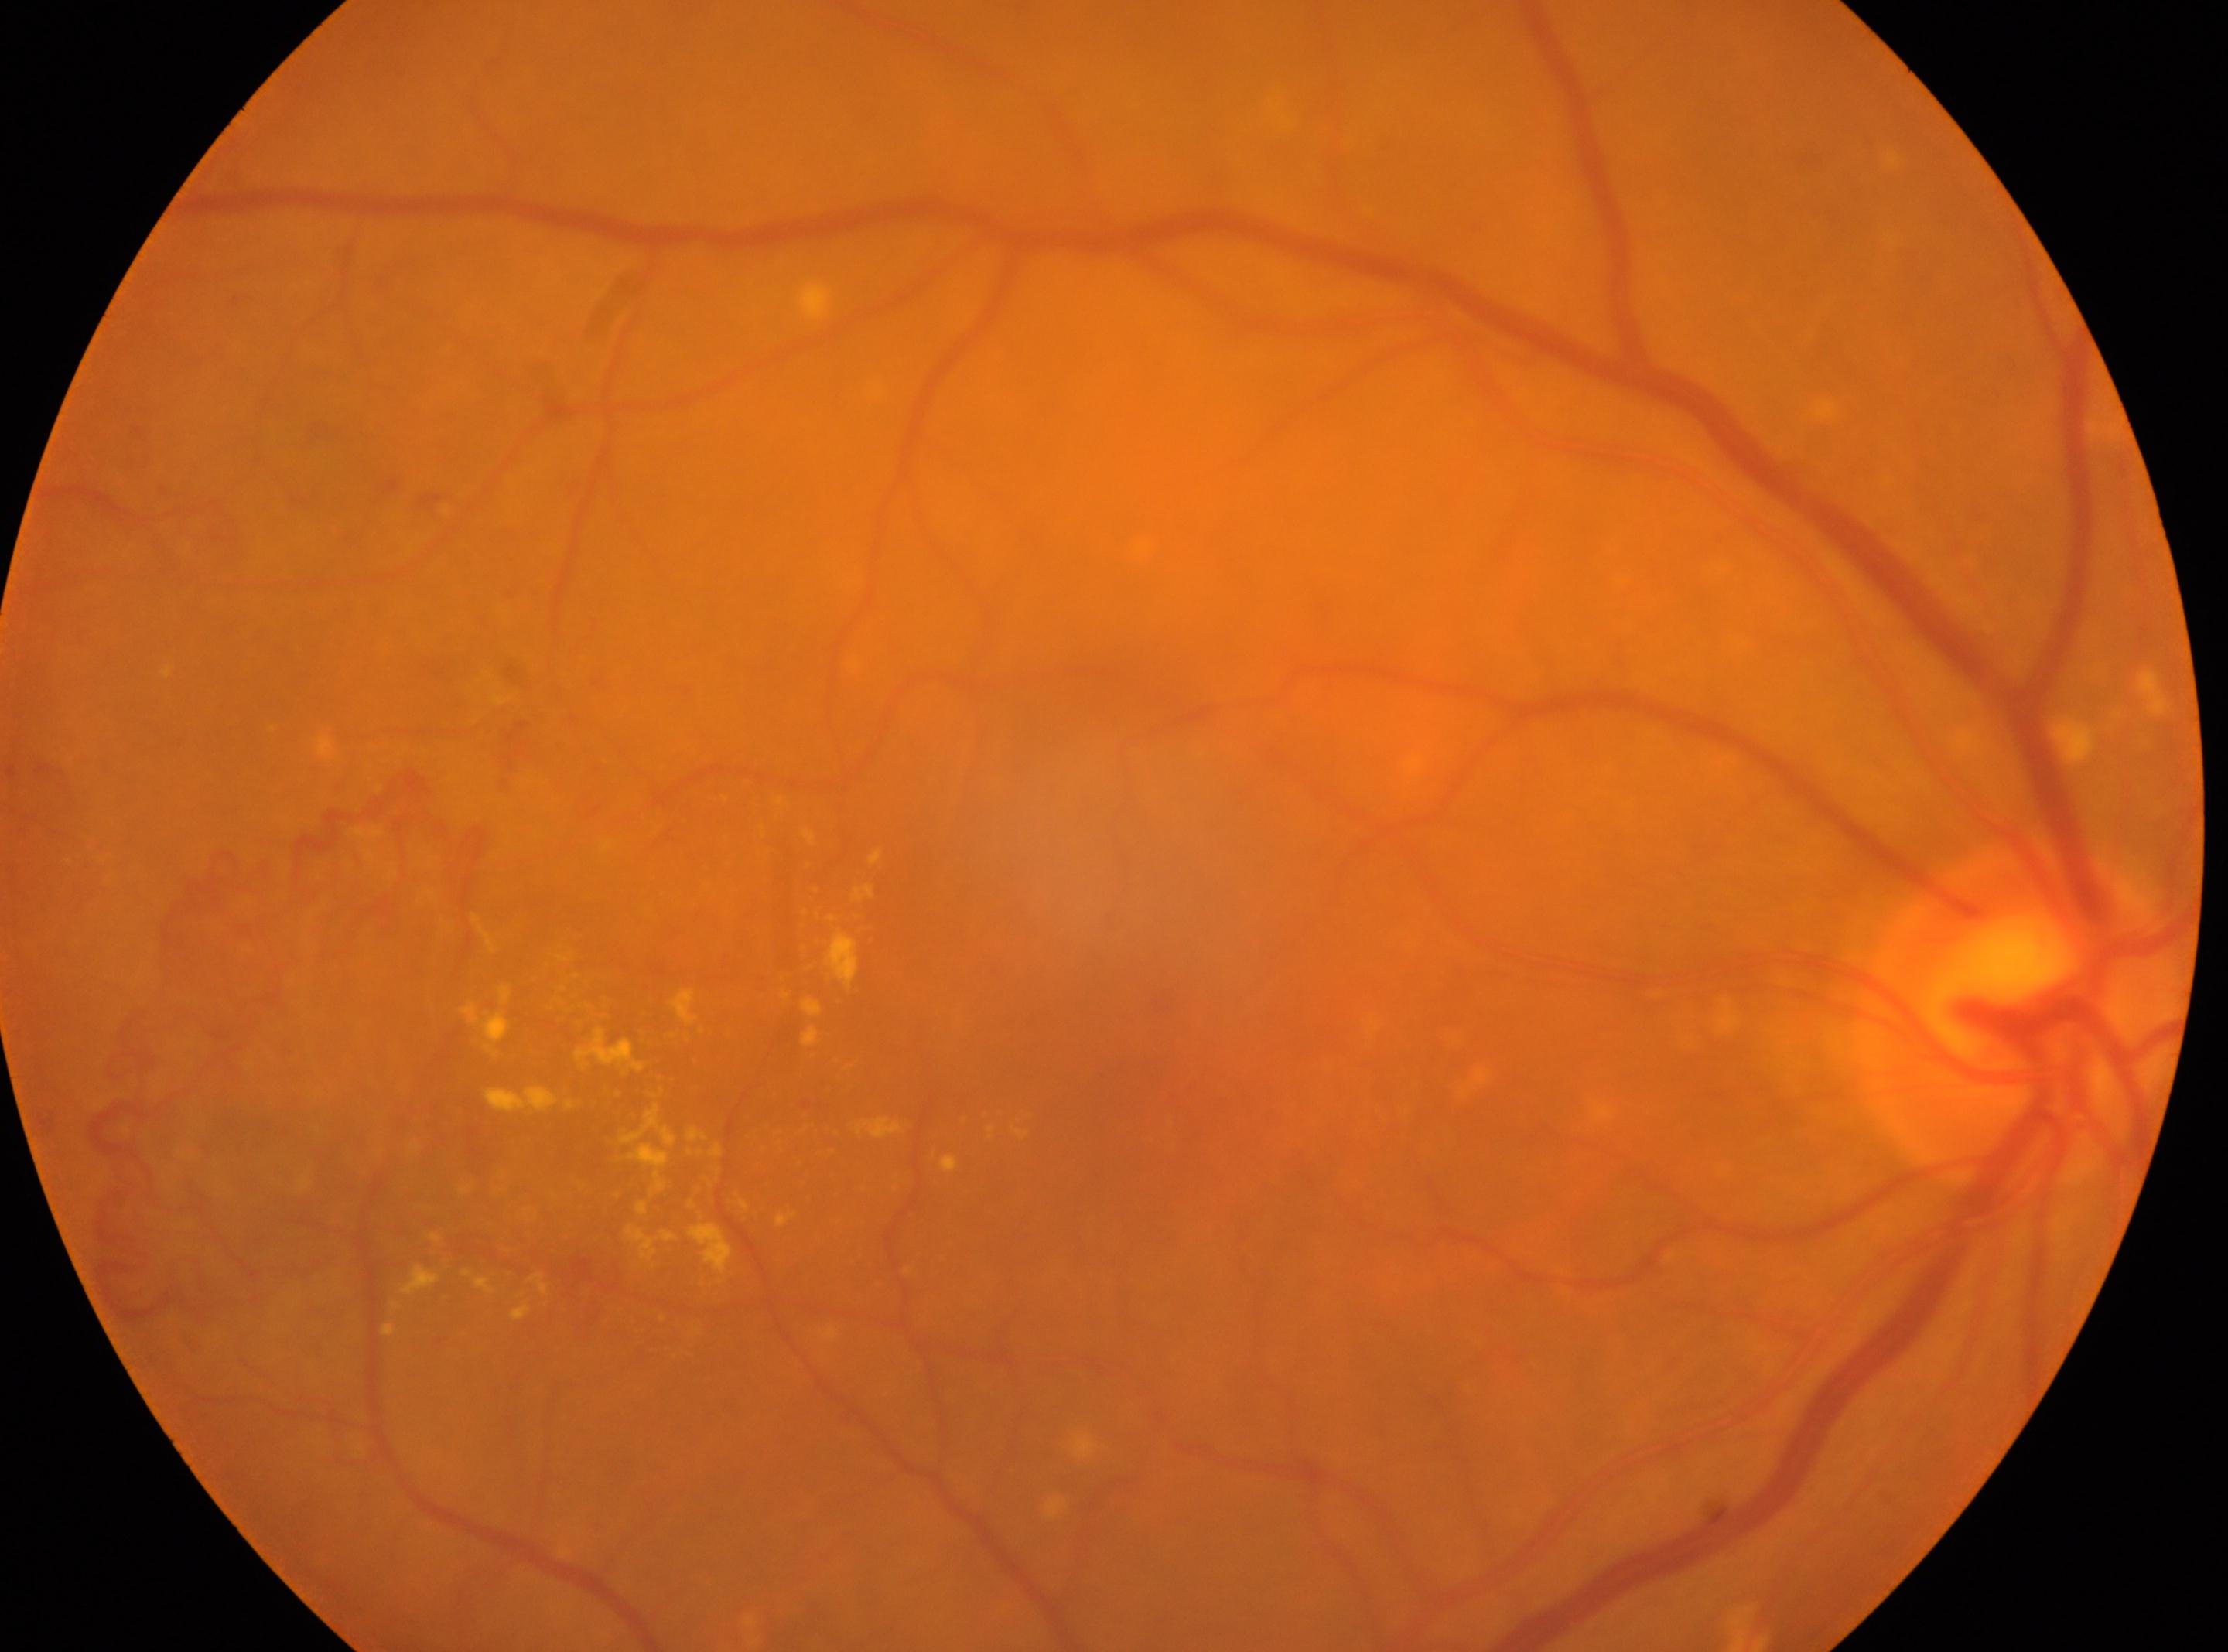 DR grade: 4. DR class: proliferative diabetic retinopathy. Optic disc located at x=2016, y=1018. Imaged eye: right. Fovea center located at x=1164, y=1067.